Color fundus image. 2048 by 1536 pixels.
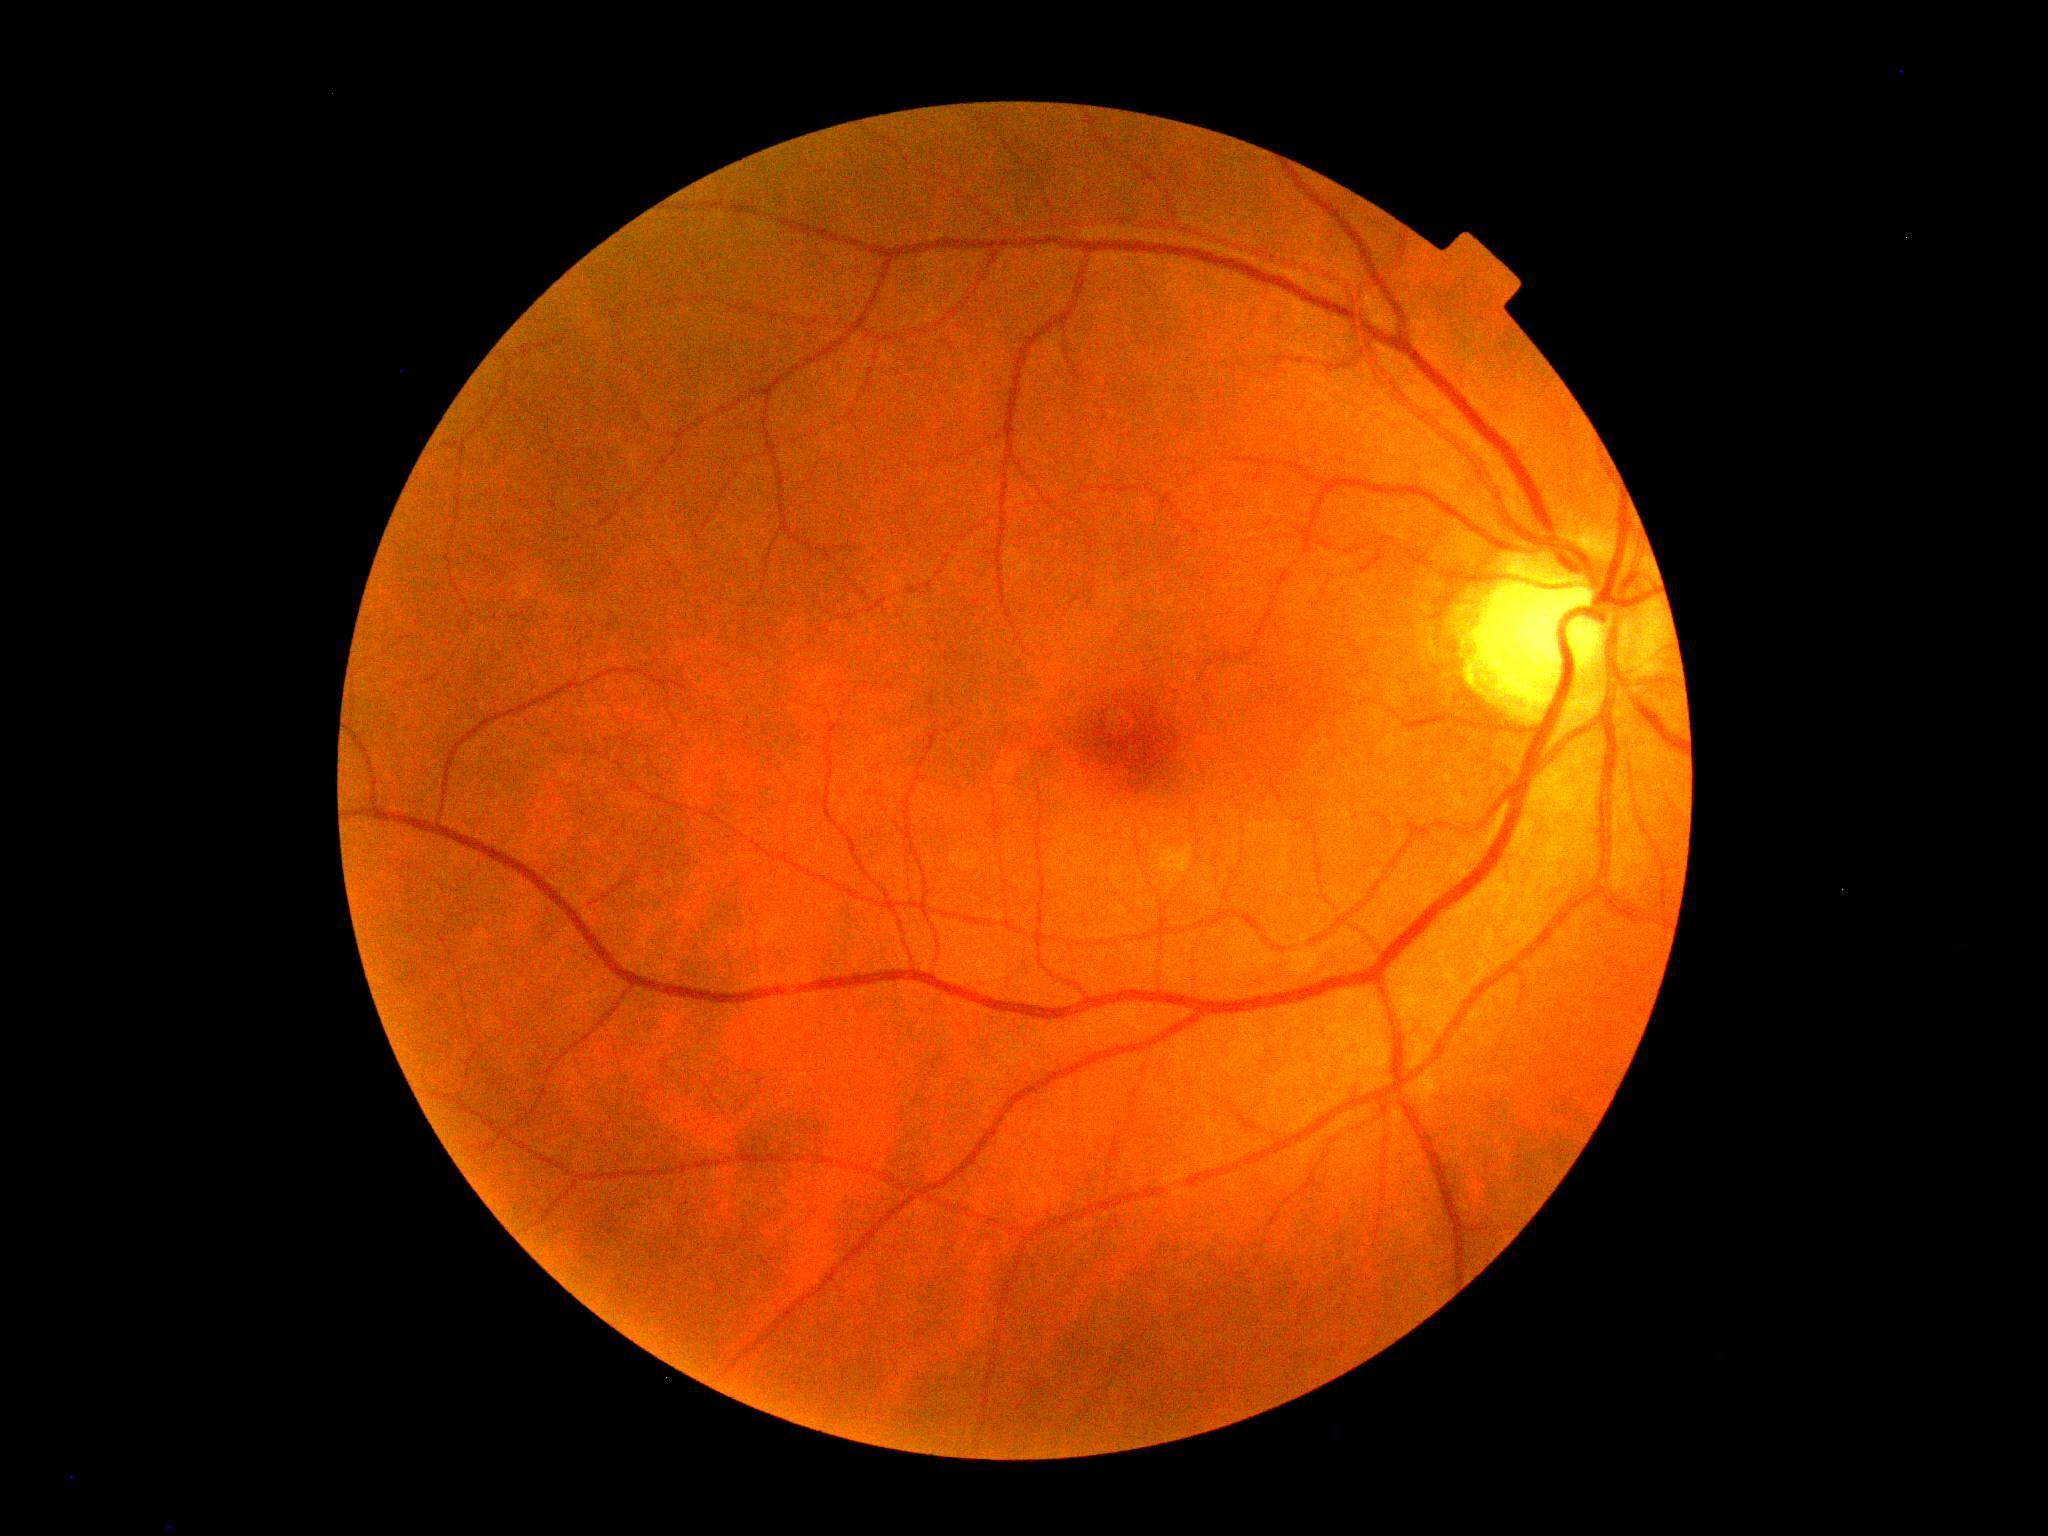 Diabetic retinopathy grade is no apparent diabetic retinopathy (0).